45-degree field of view; CFP; DR severity per modified Davis staging.
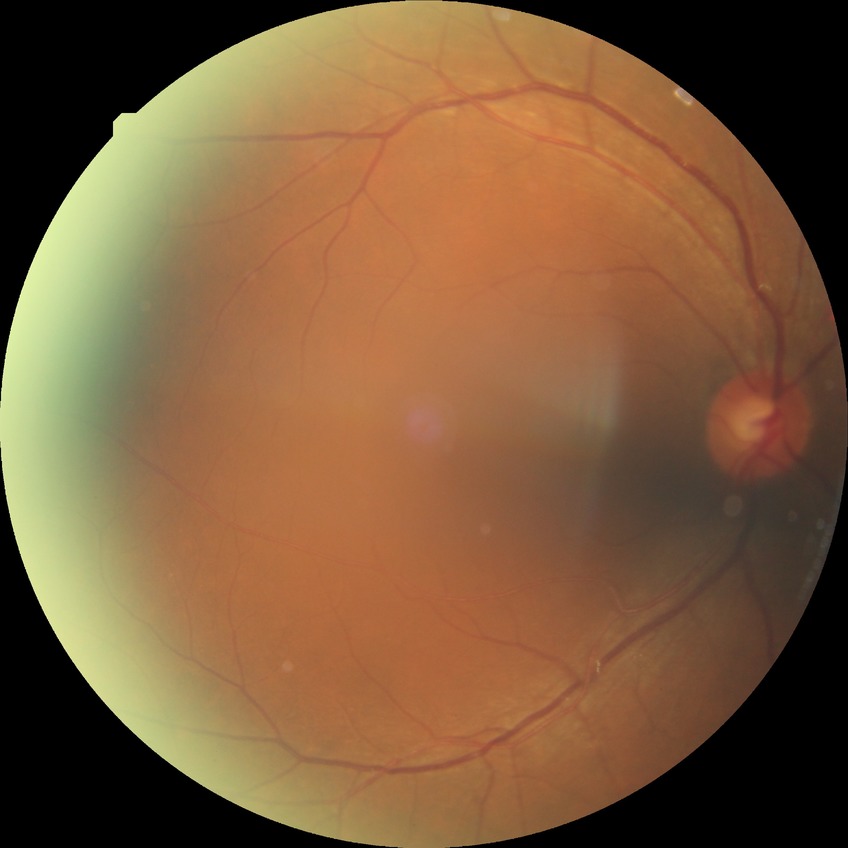 Diabetic retinopathy (DR): NDR (no diabetic retinopathy).